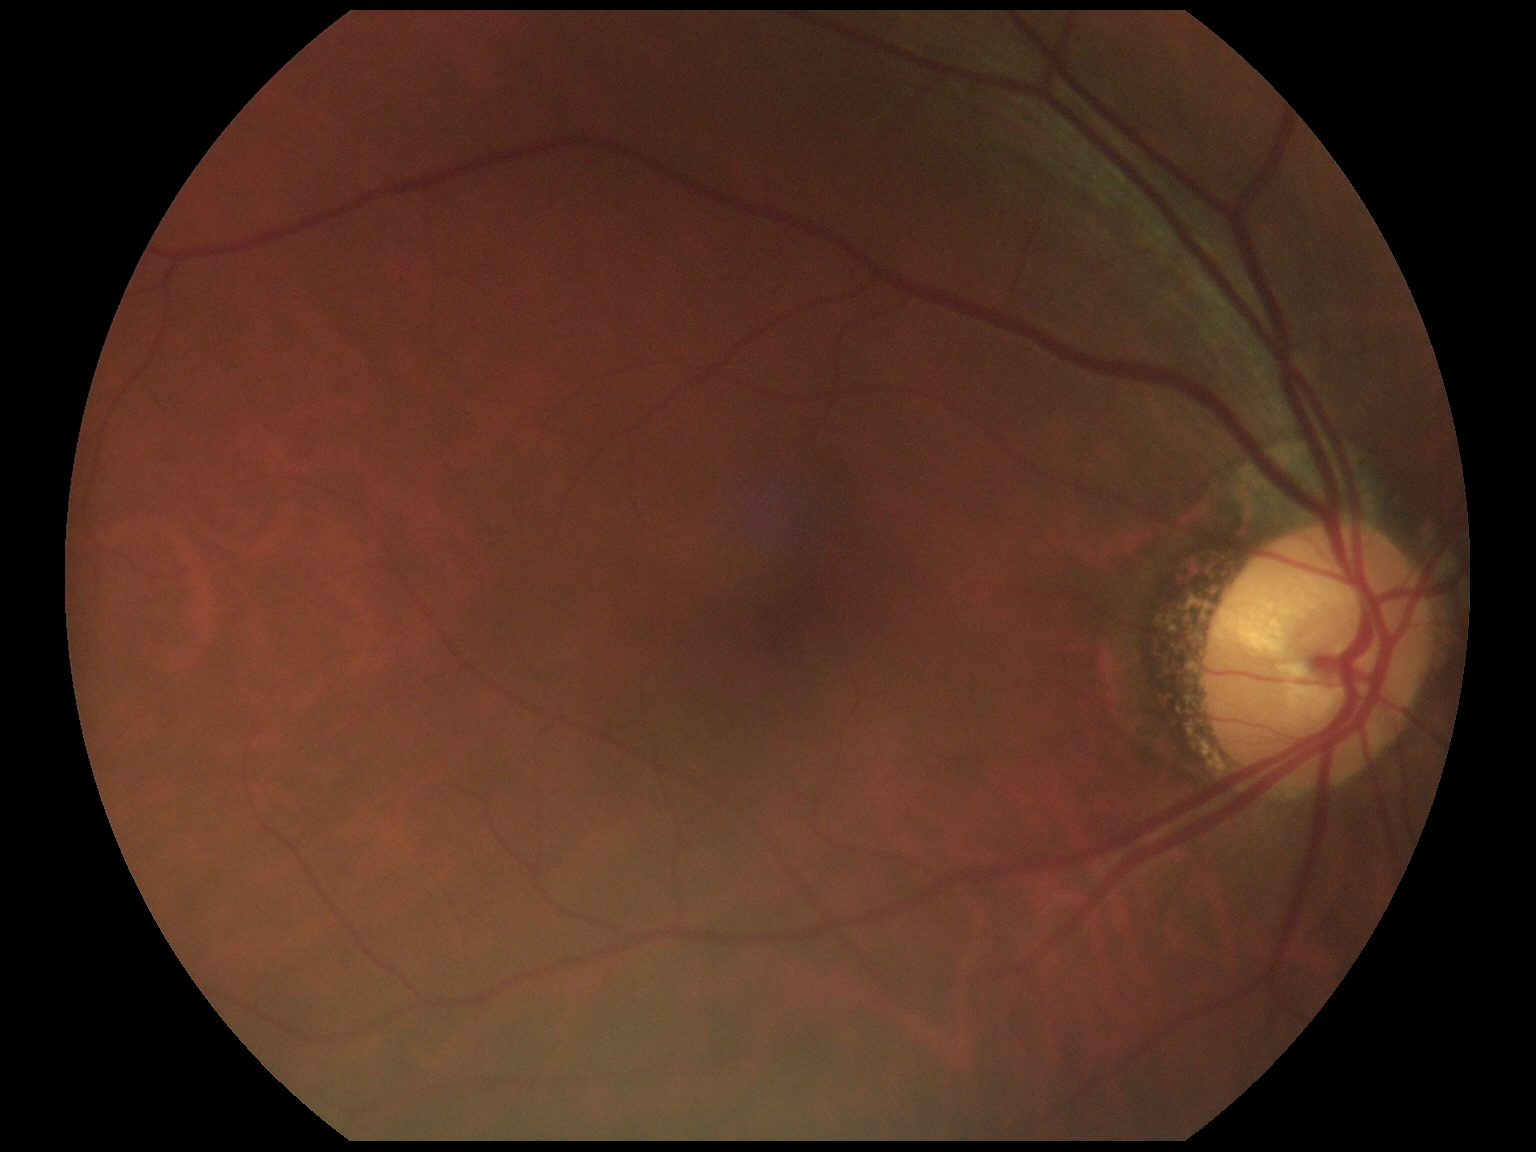 diabetic retinopathy severity@0.